45° FOV; retinal fundus photograph: 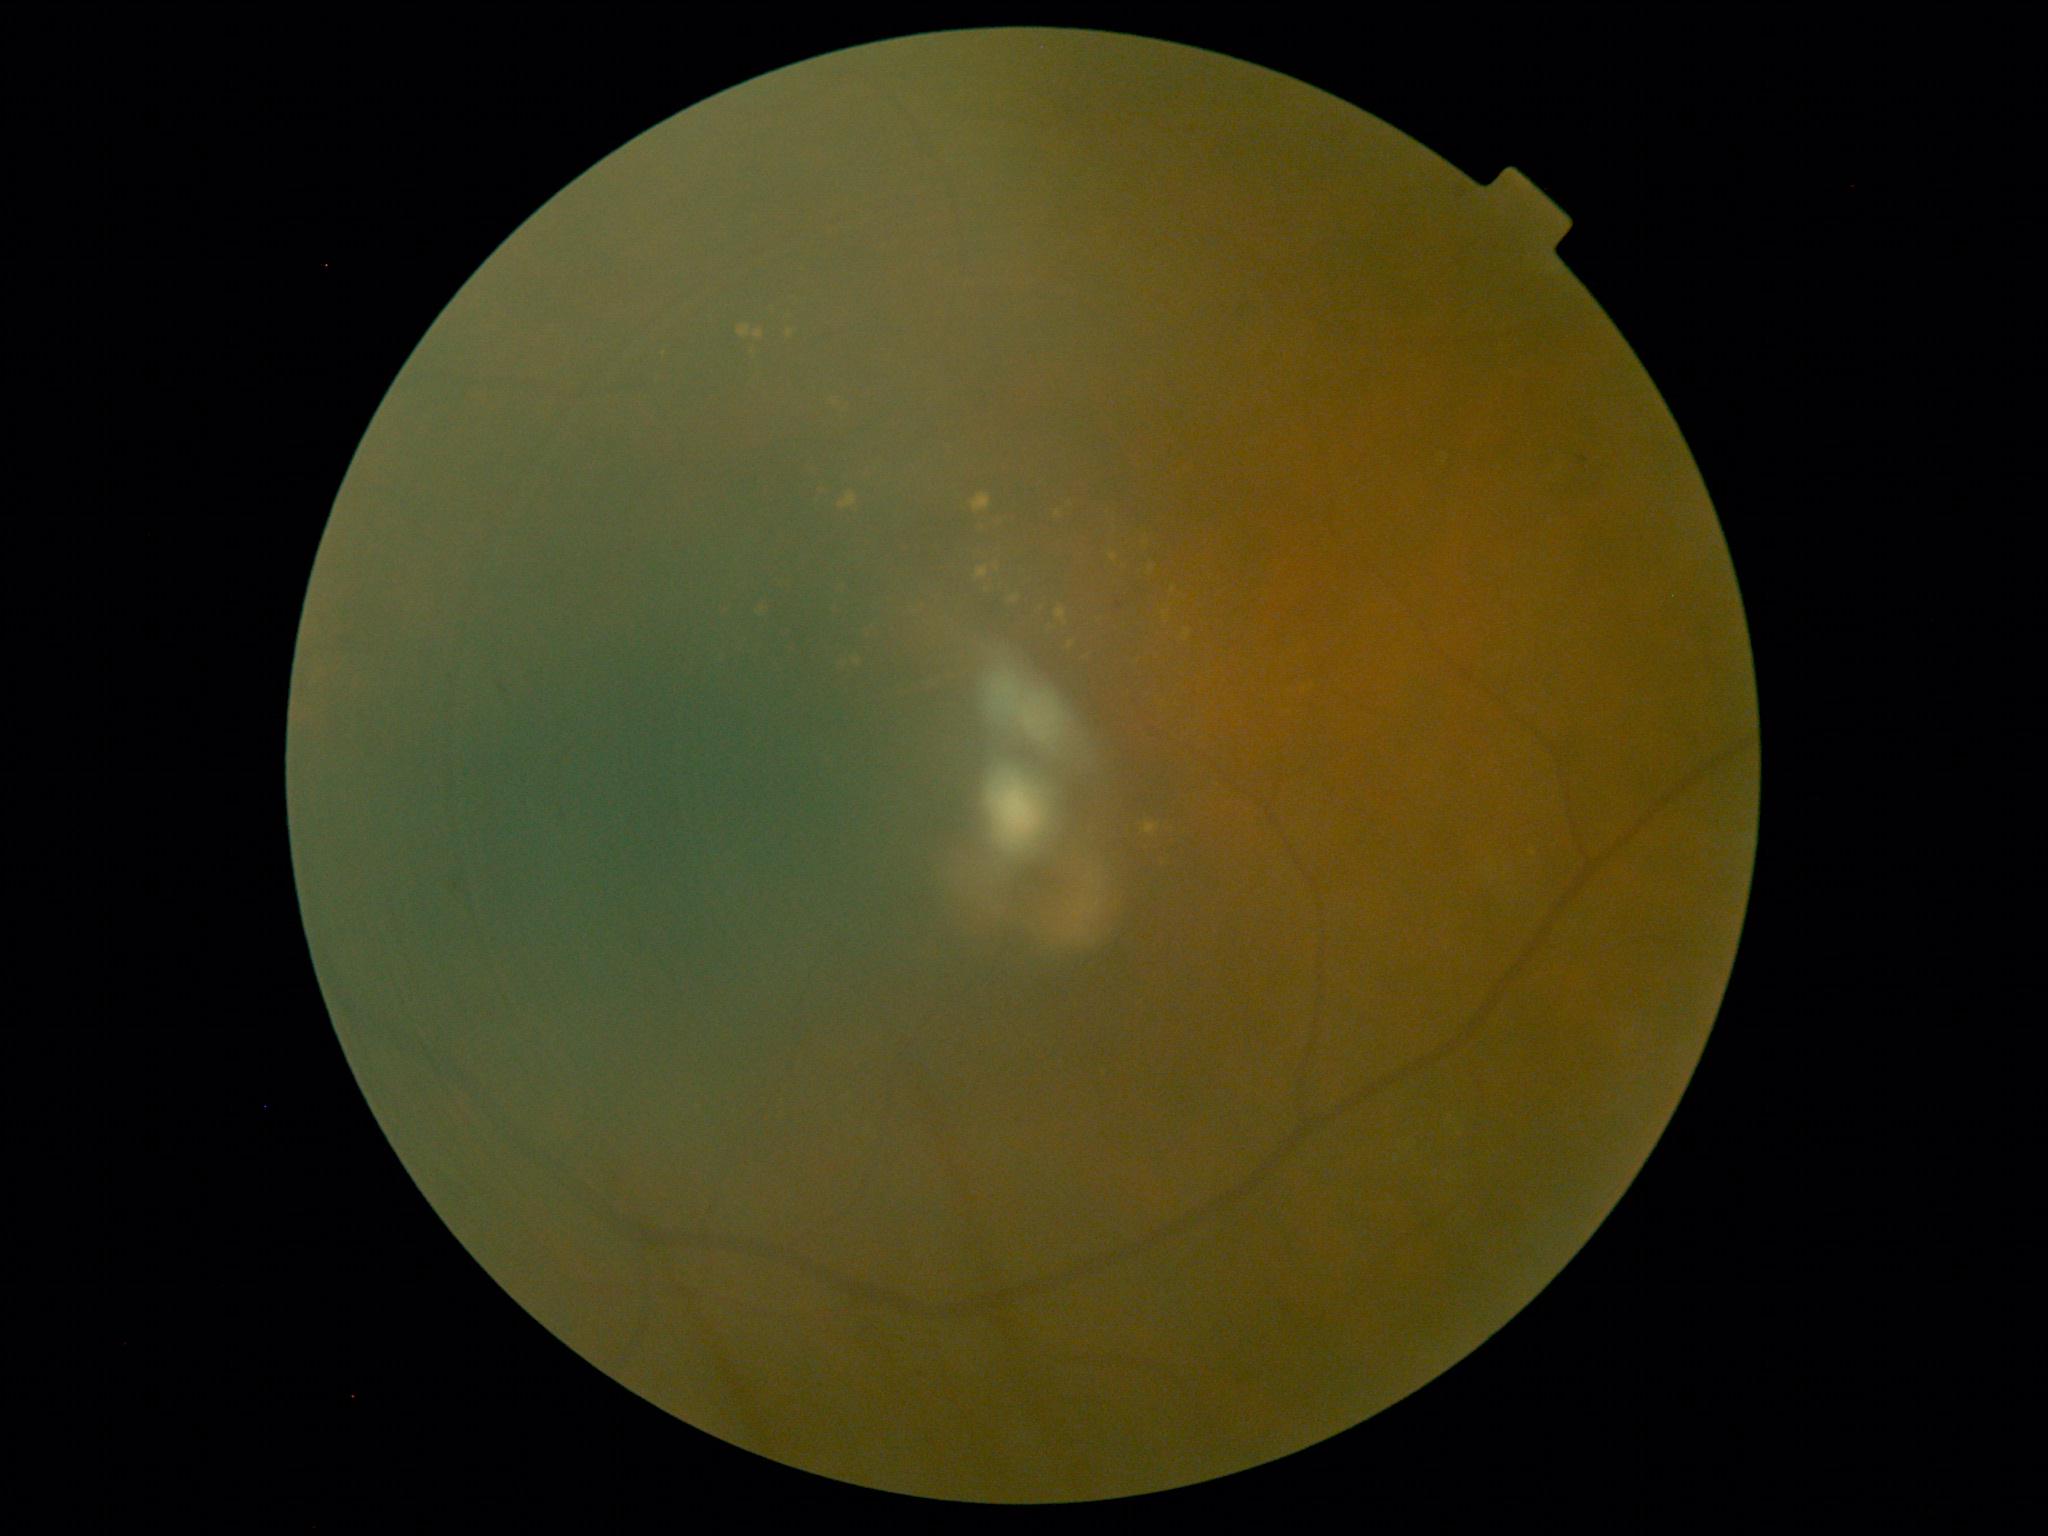
Diabetic retinopathy severity: moderate non-proliferative diabetic retinopathy (grade 2).
The retinopathy is classified as non-proliferative diabetic retinopathy.